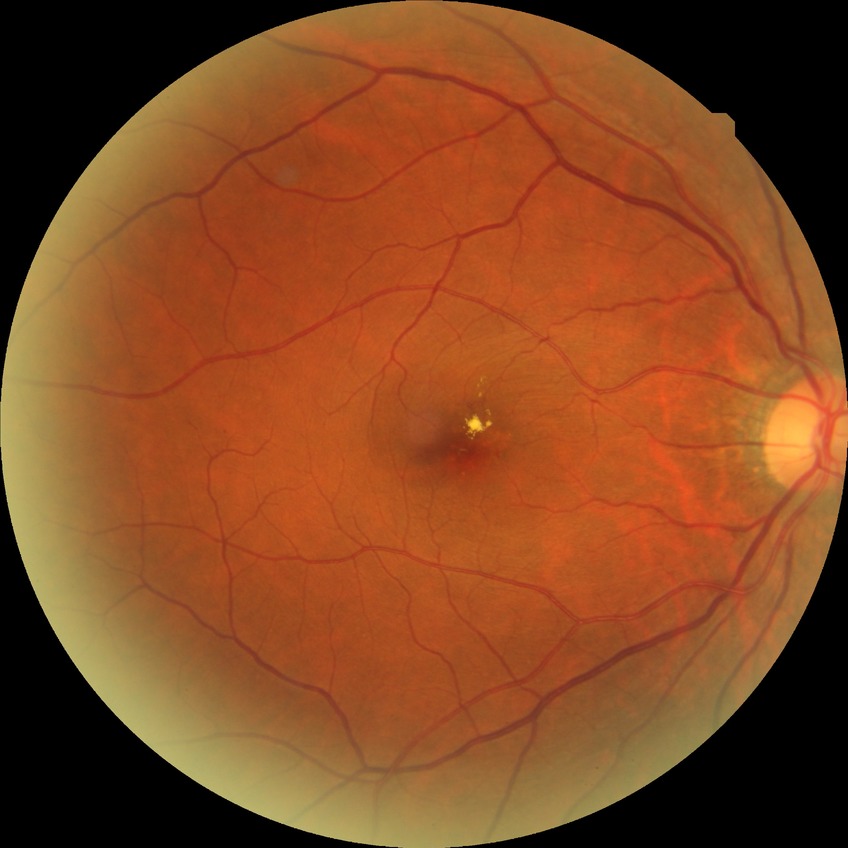

Findings:
– diabetic retinopathy (DR) — simple diabetic retinopathy (SDR)